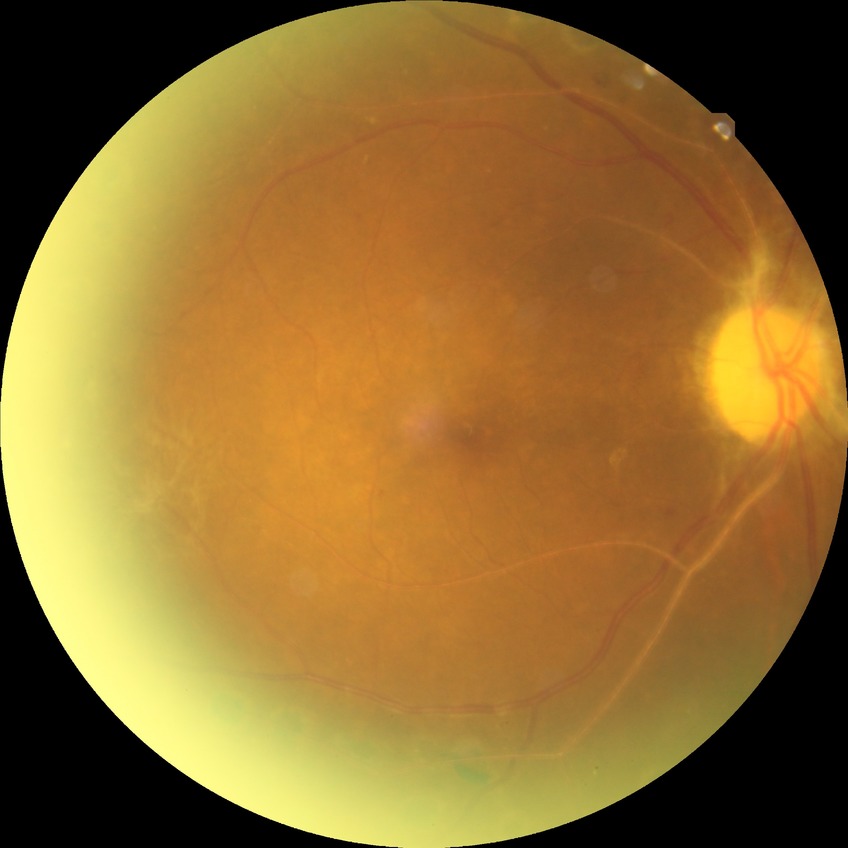 DR grade is PDR.